Acquired with a NIDEK AFC-230 · fundus photo — 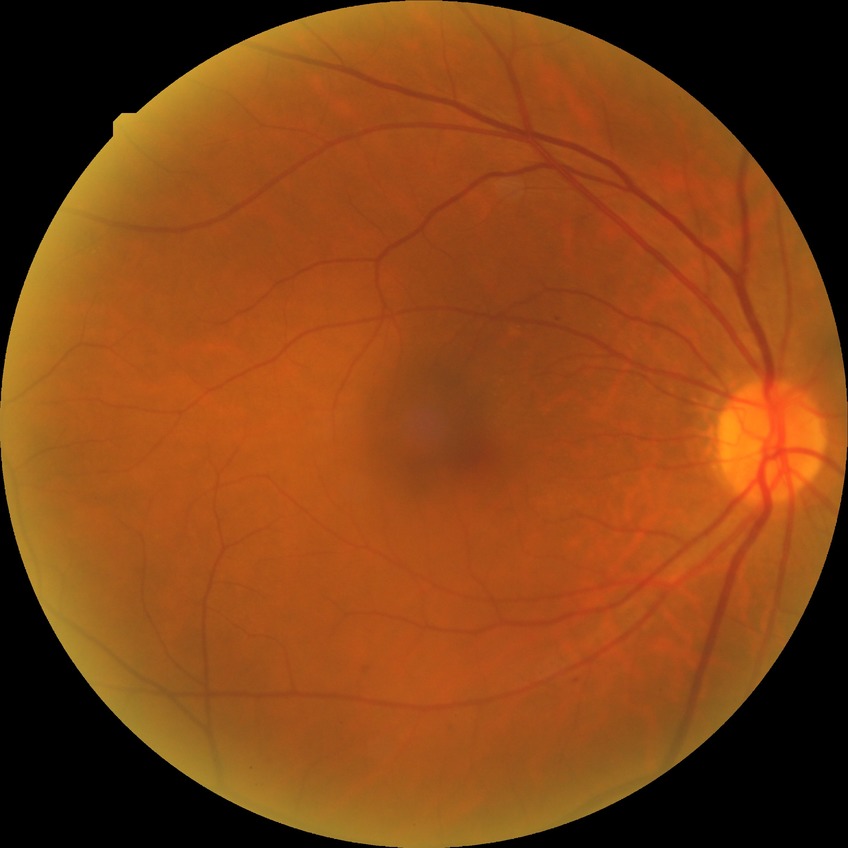
{"davis_grade": "simple diabetic retinopathy (SDR)"}